Wide-field fundus photograph from neonatal ROP screening:
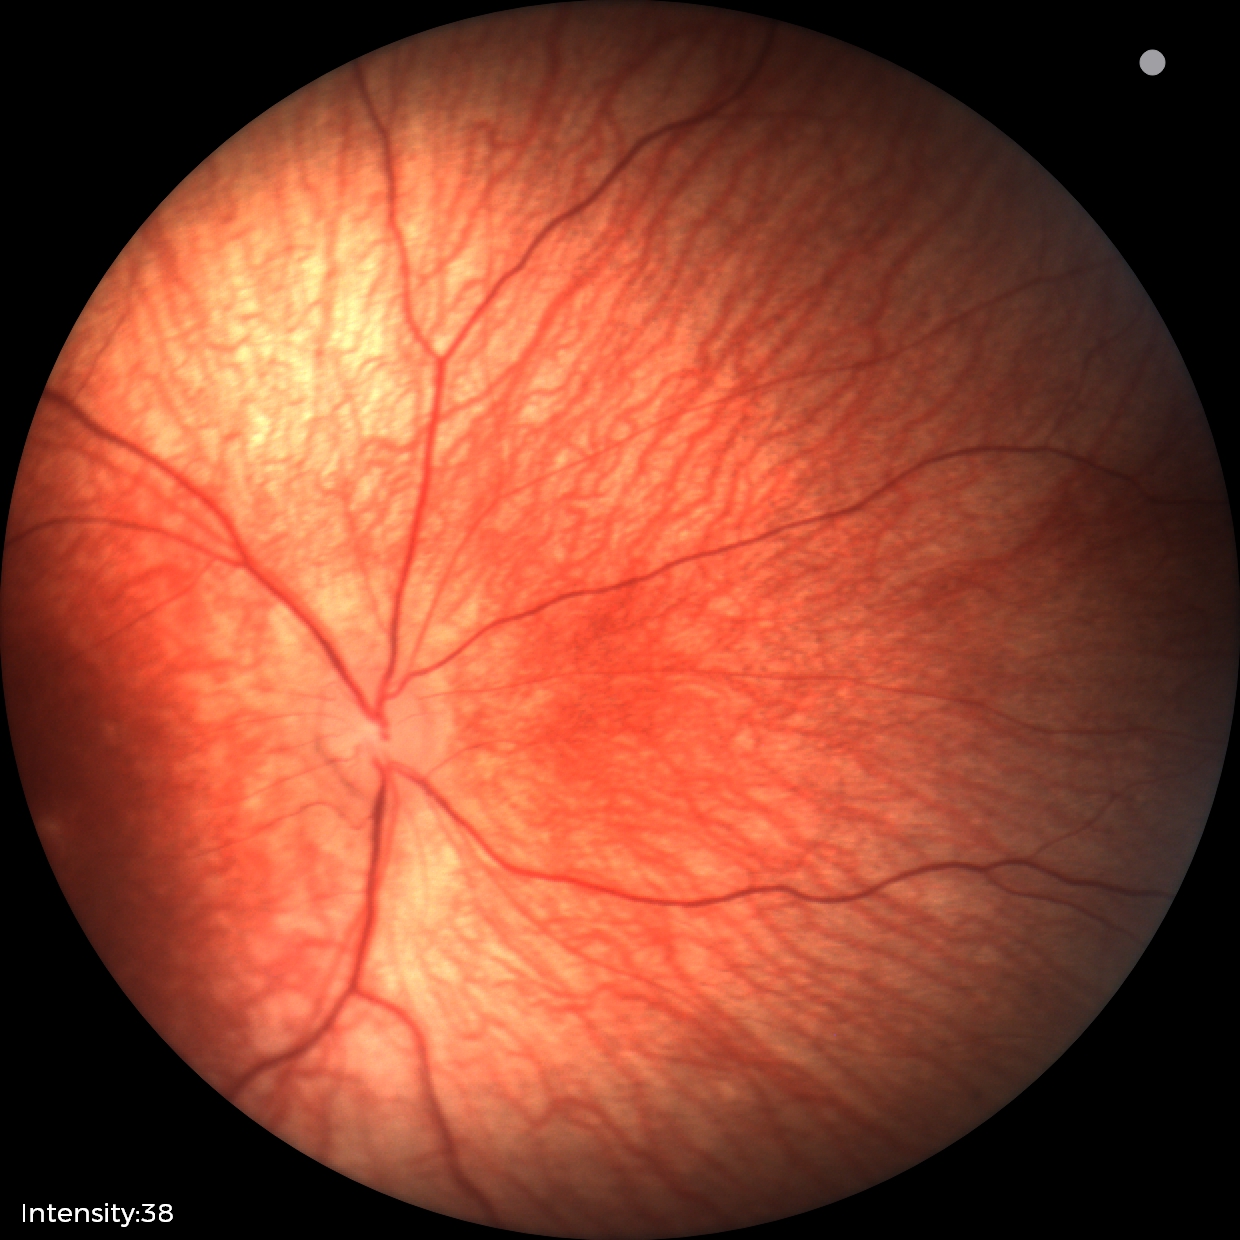 No retinal pathology identified on screening.